Image size 1240x1240; Phoenix ICON, 100° FOV; infant wide-field retinal image
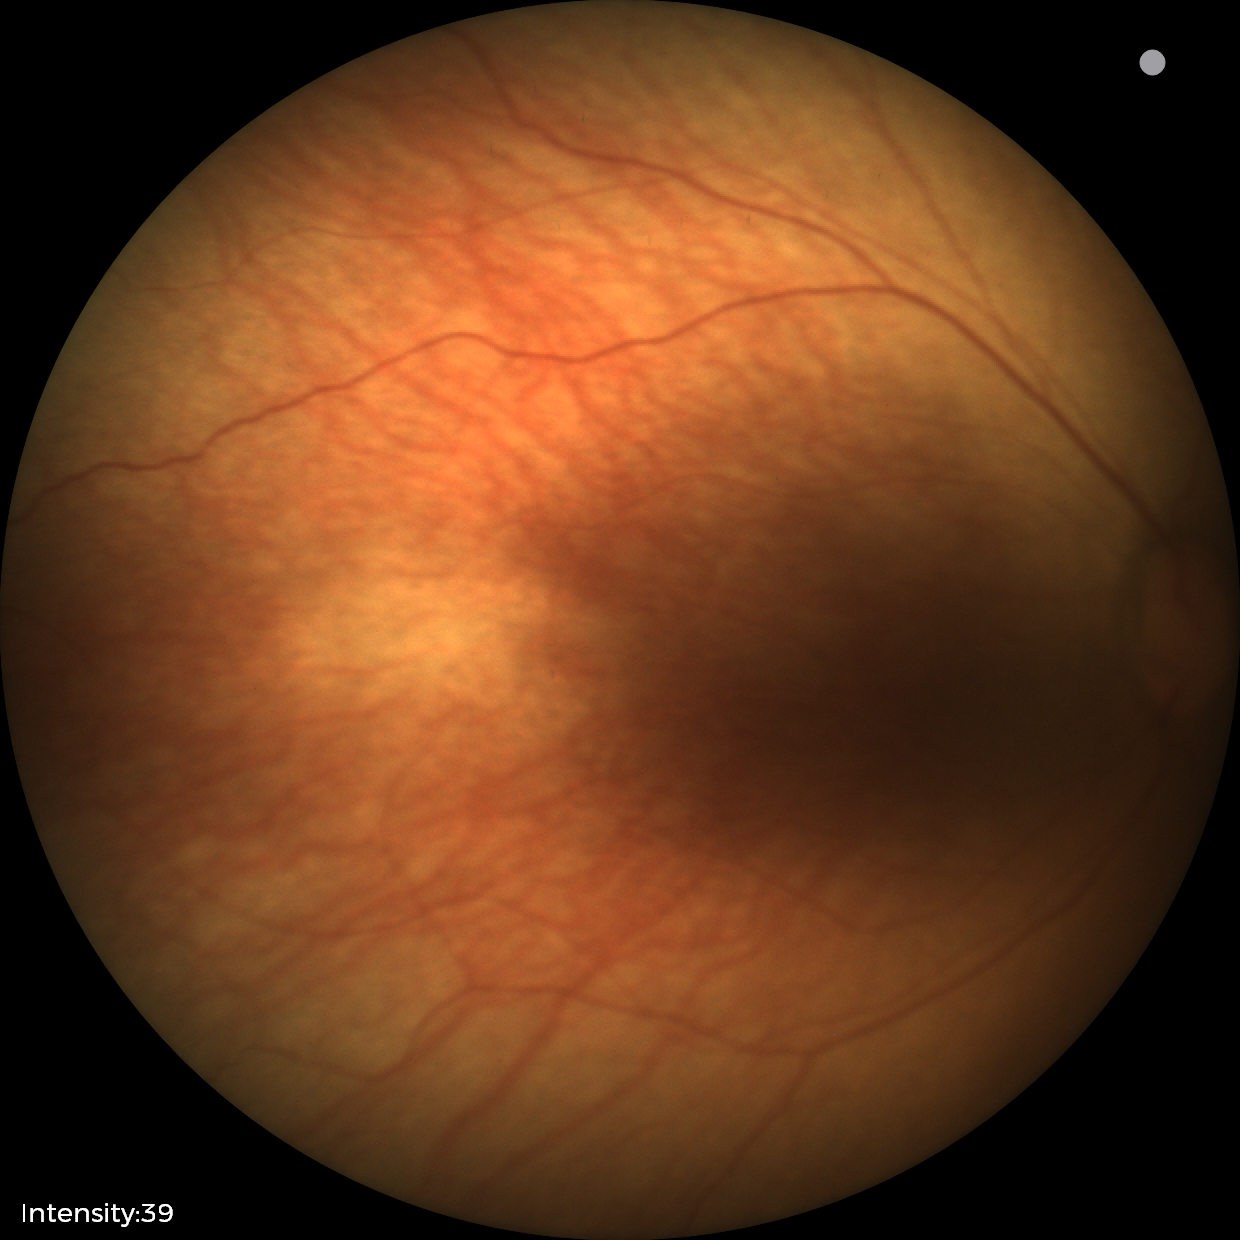
Normal screening examination.